No pharmacologic dilation; 45 degree fundus photograph; image size 848x848; Davis DR grading; fundus photo; camera: NIDEK AFC-230.
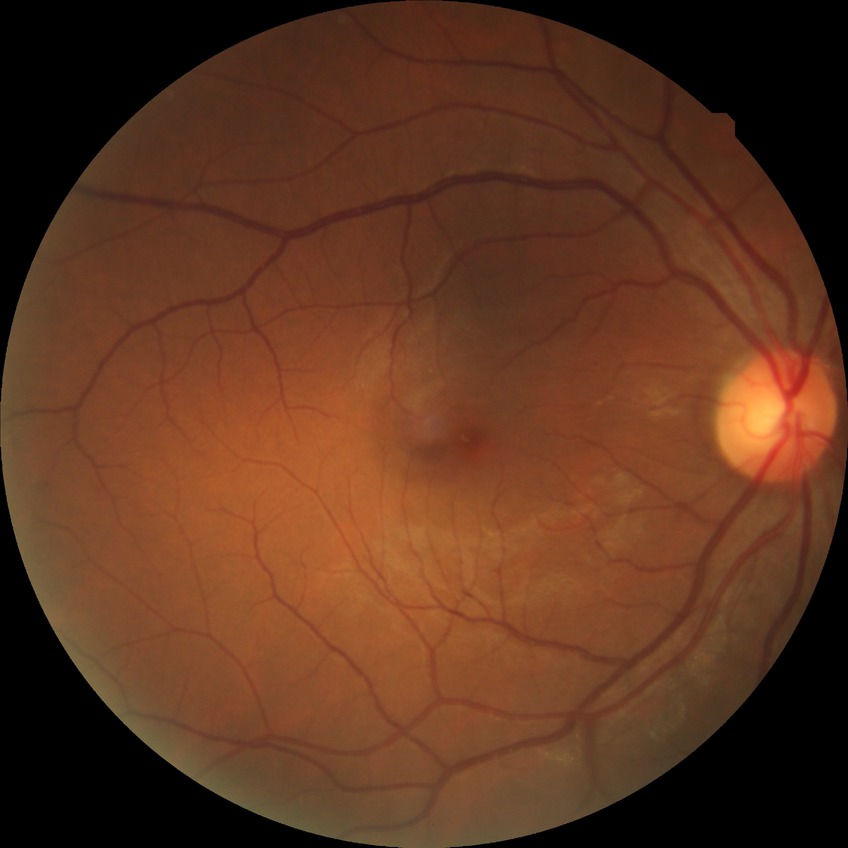

  davis_grade: no diabetic retinopathy (NDR)